45° FOV · 1932x1916.
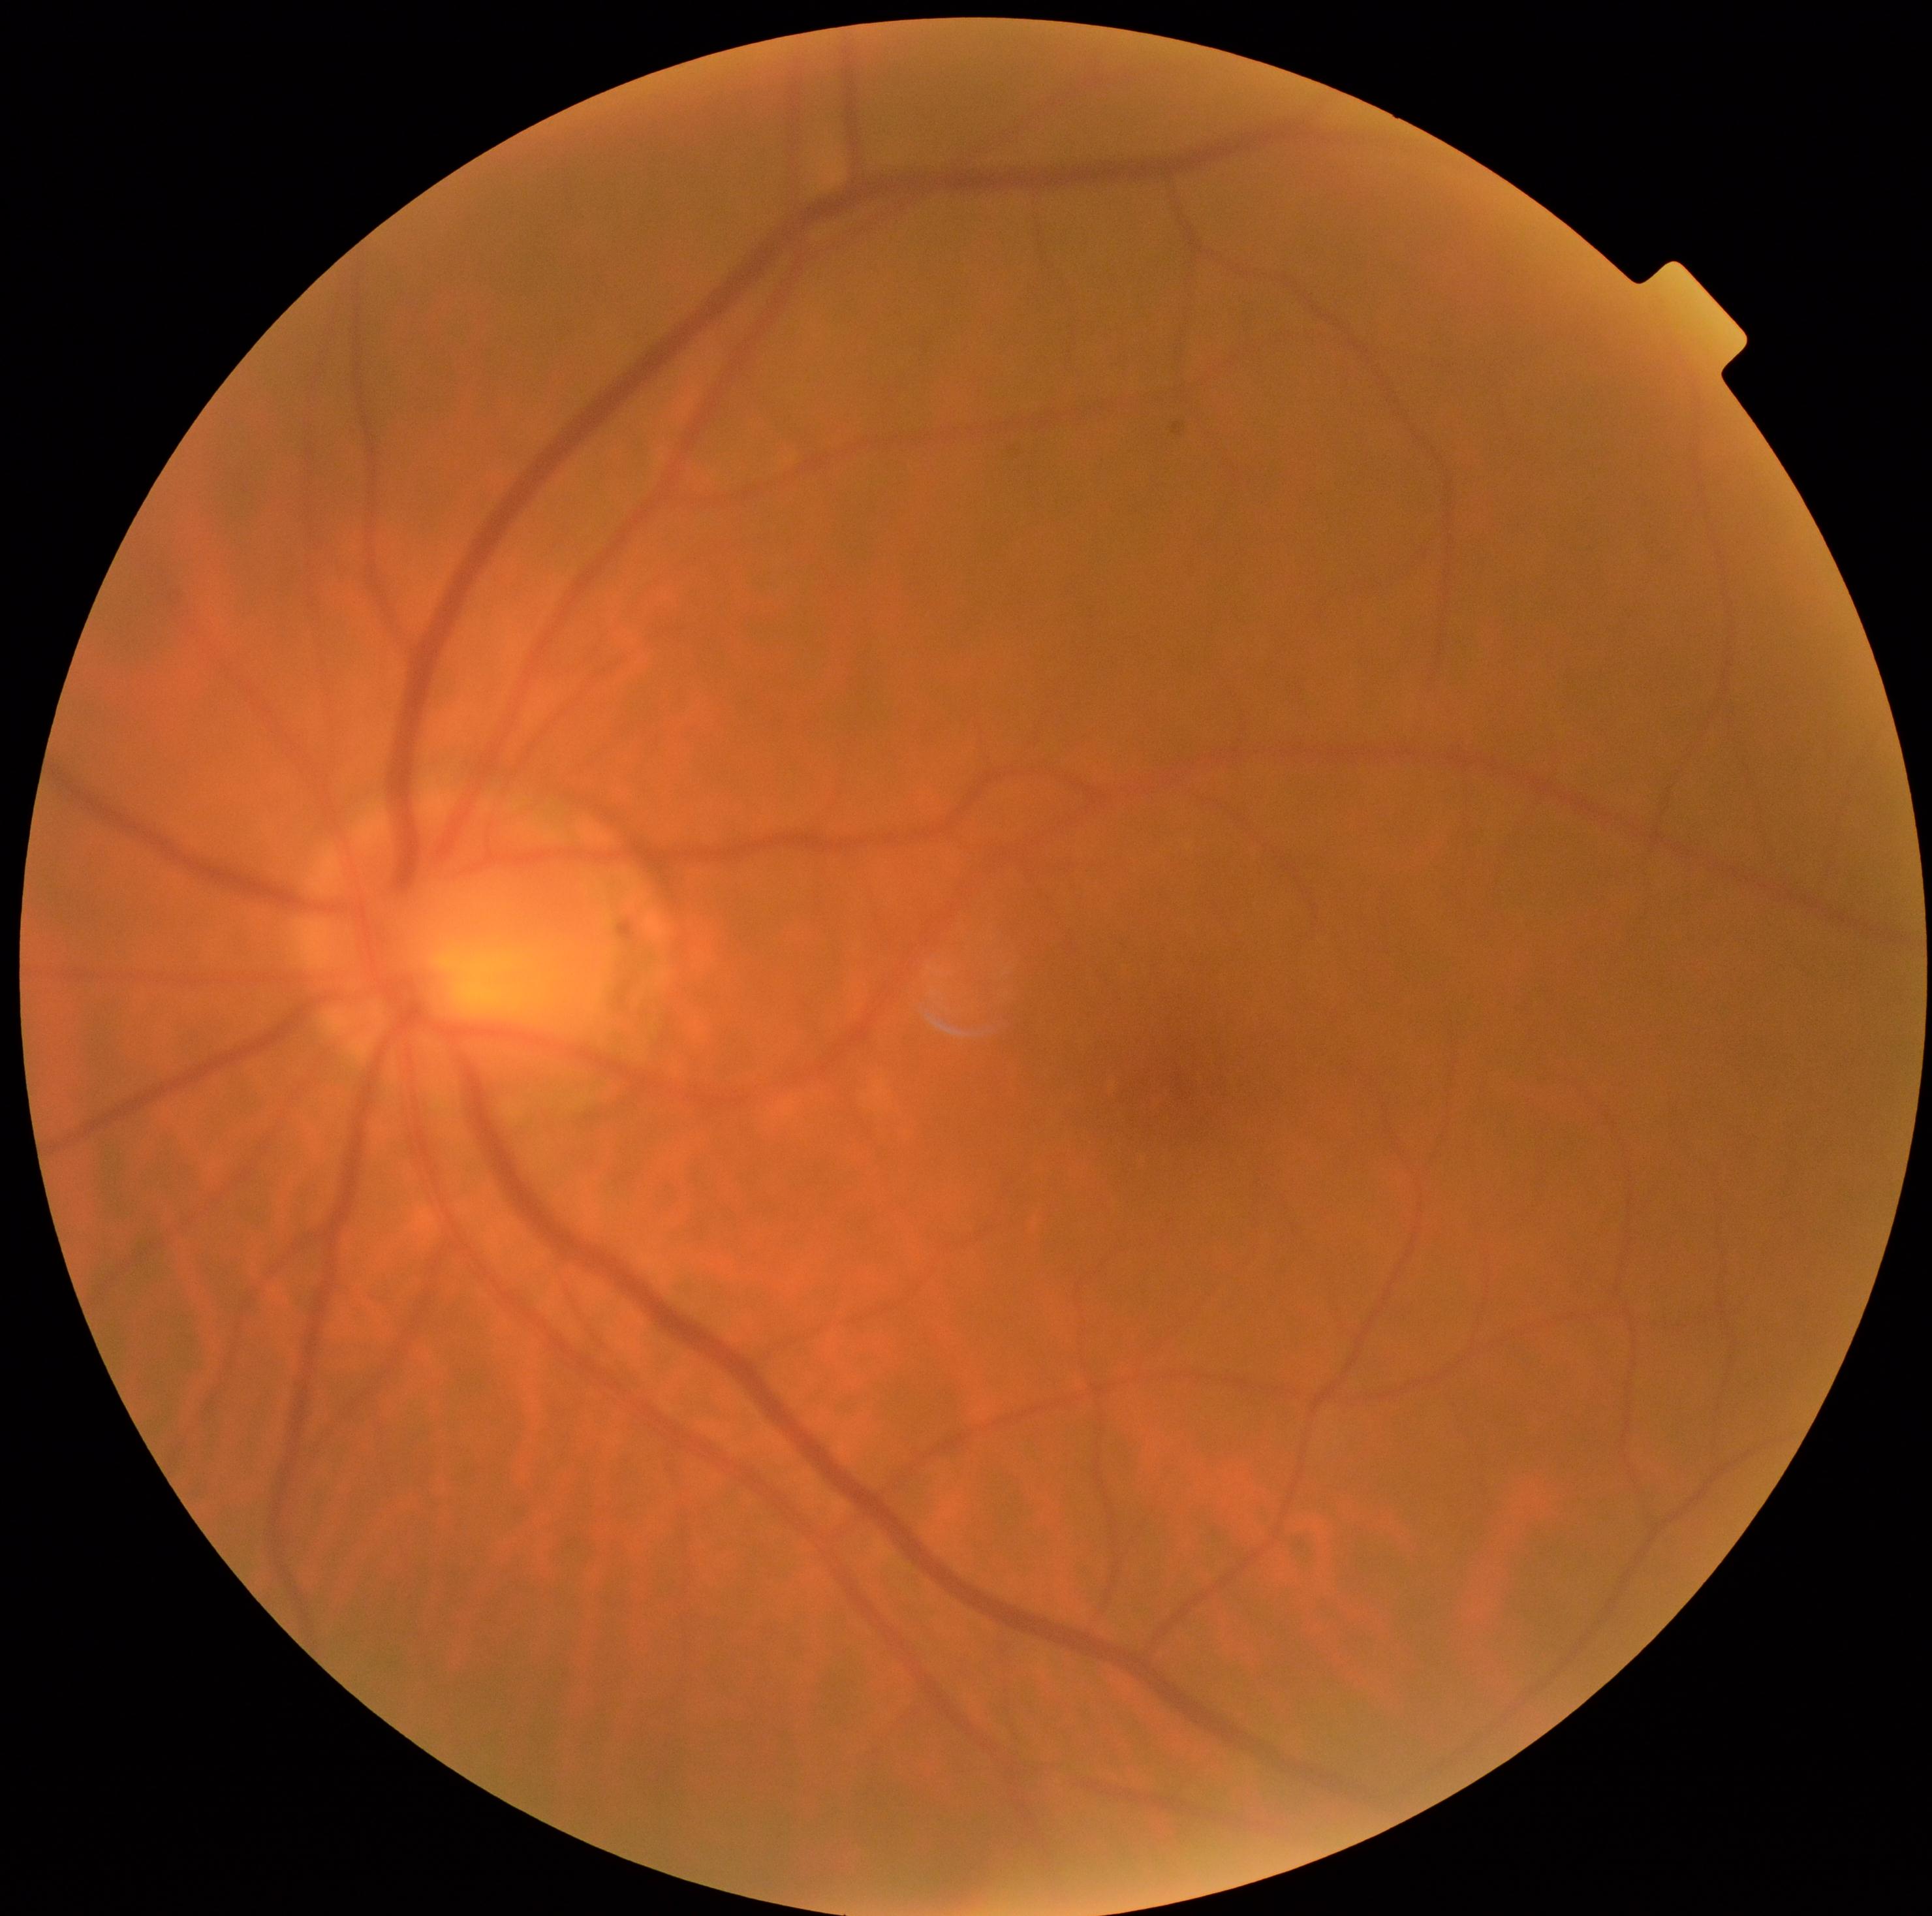
DR = grade 0.